Captured with the Clarity RetCam 3 (130° field of view). 640x480px. Infant wide-field fundus photograph.
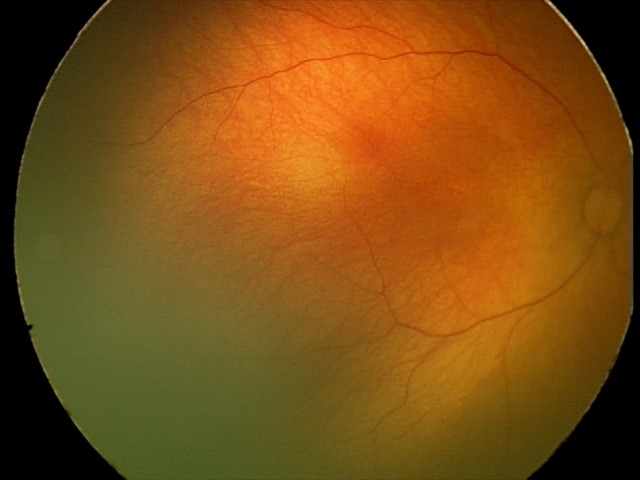
Examination with physiological retinal findings.